Phoenix ICON wide-field infant fundus image
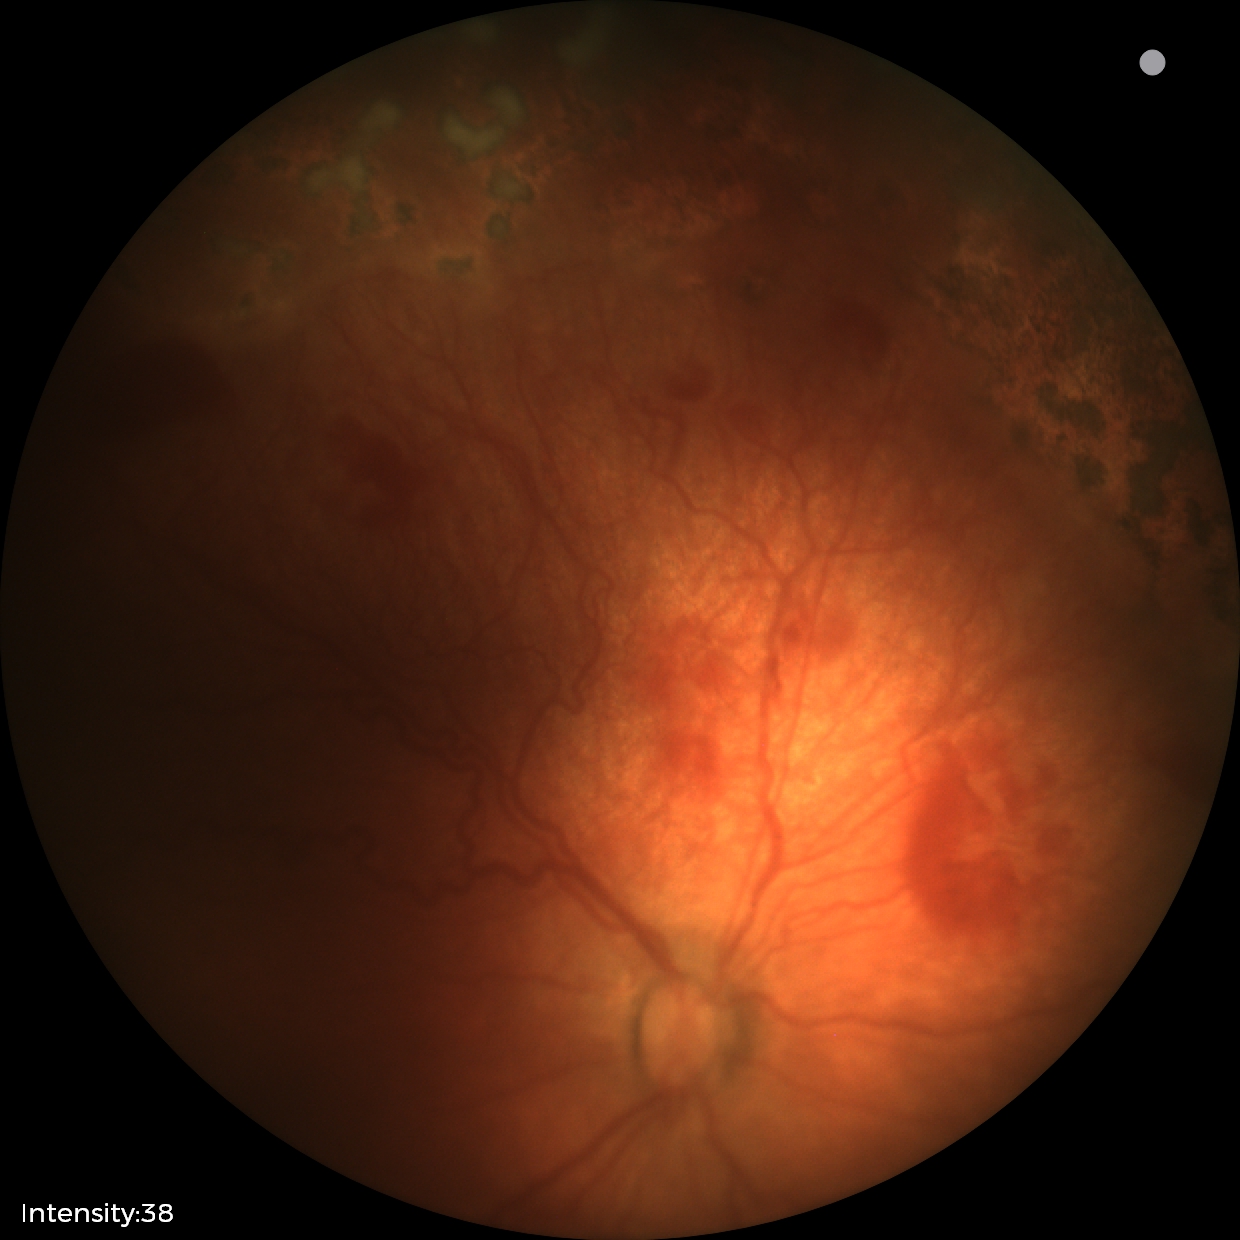
Diagnosis: status post retinopathy of prematurity (ROP); plus disease: absent.